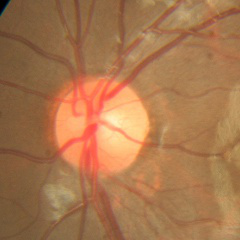
Q: What stage of glaucoma is present?
A: No glaucomatous changes.